CFP — 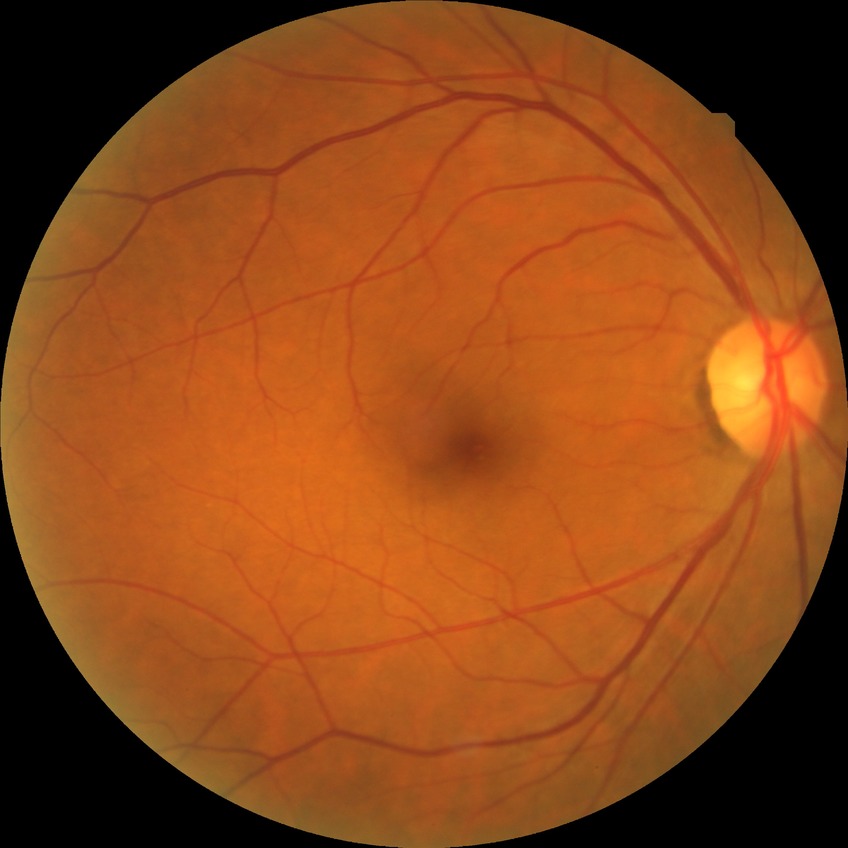
retinopathy stage@no diabetic retinopathy.